DR severity per modified Davis staging: 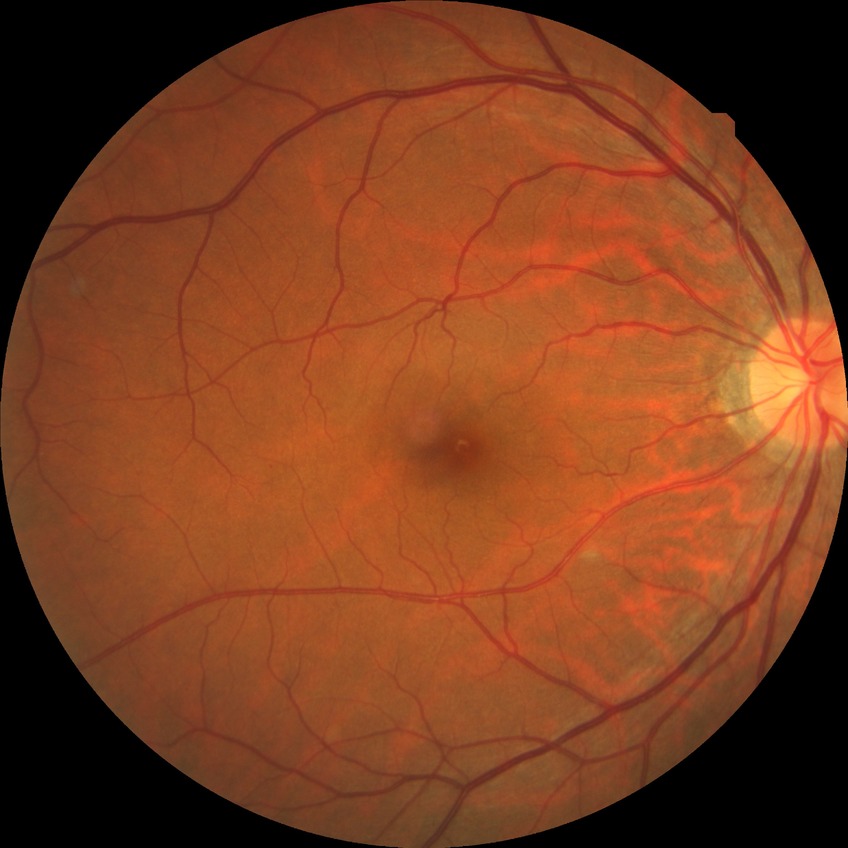
diabetic retinopathy (DR)@no diabetic retinopathy (NDR).